45-degree field of view. Color fundus image.
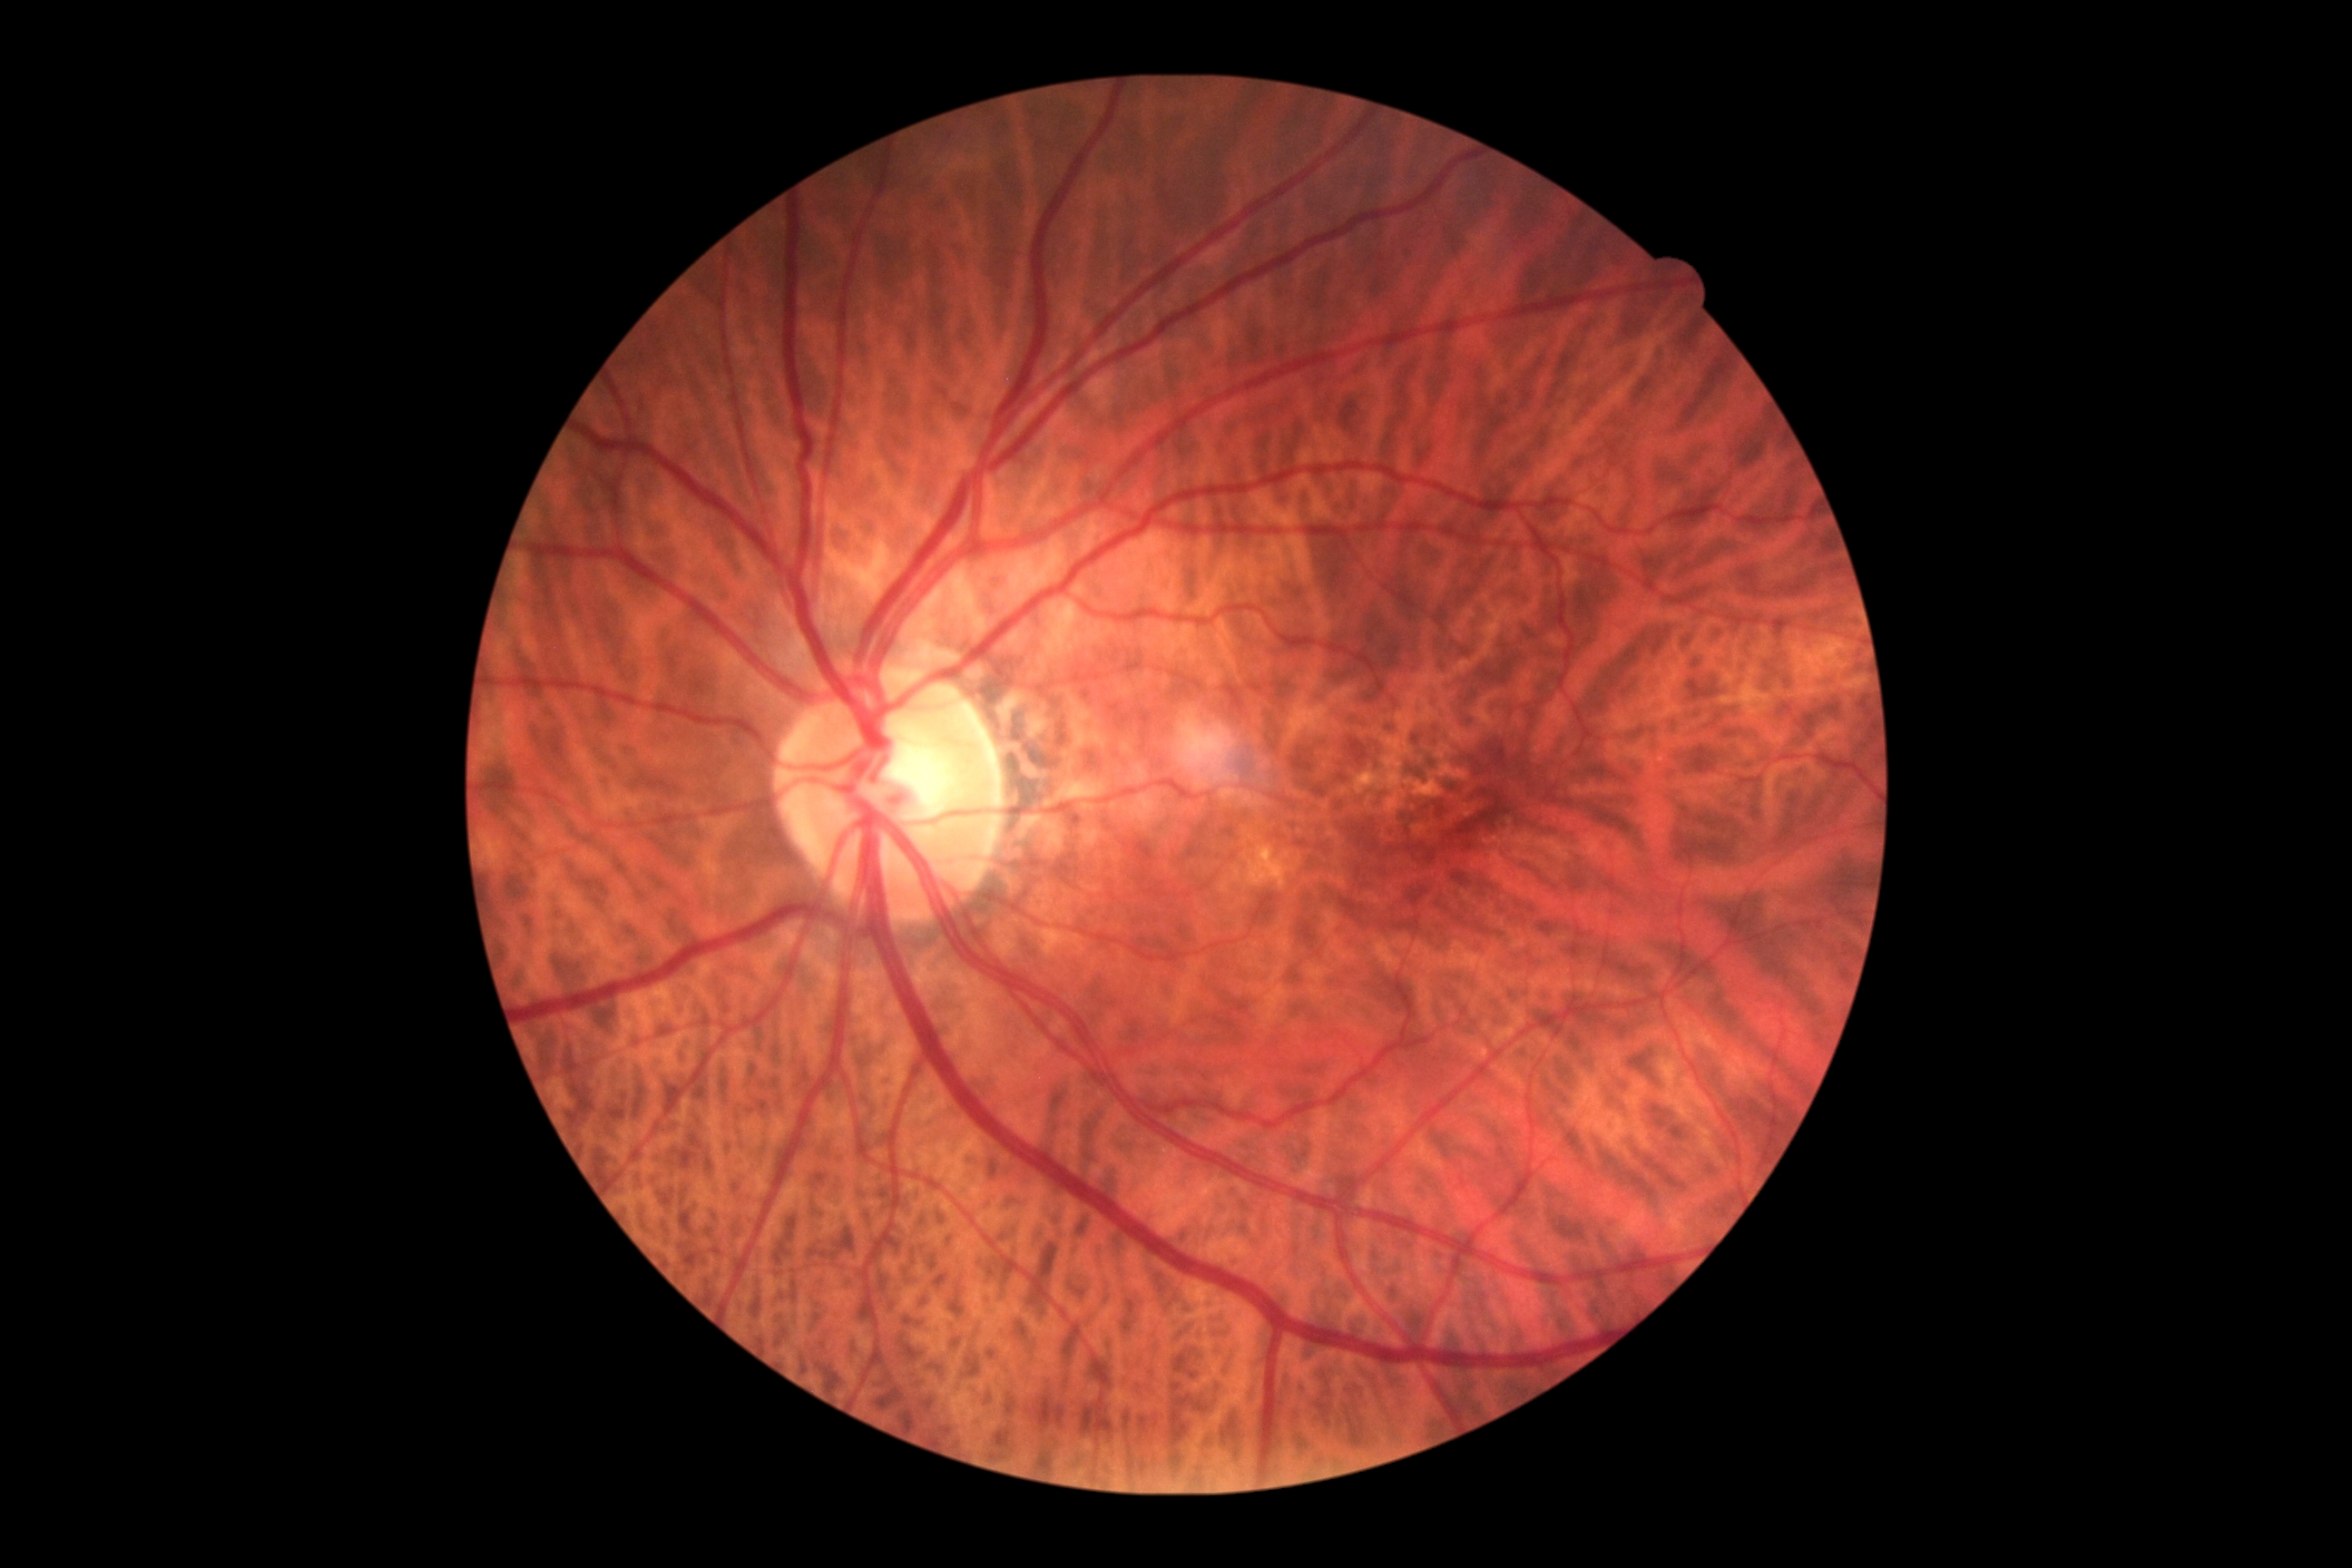
No apparent diabetic retinopathy.
DR severity is grade 0 (no apparent retinopathy).